CFP · 2352x1568 · 45-degree field of view
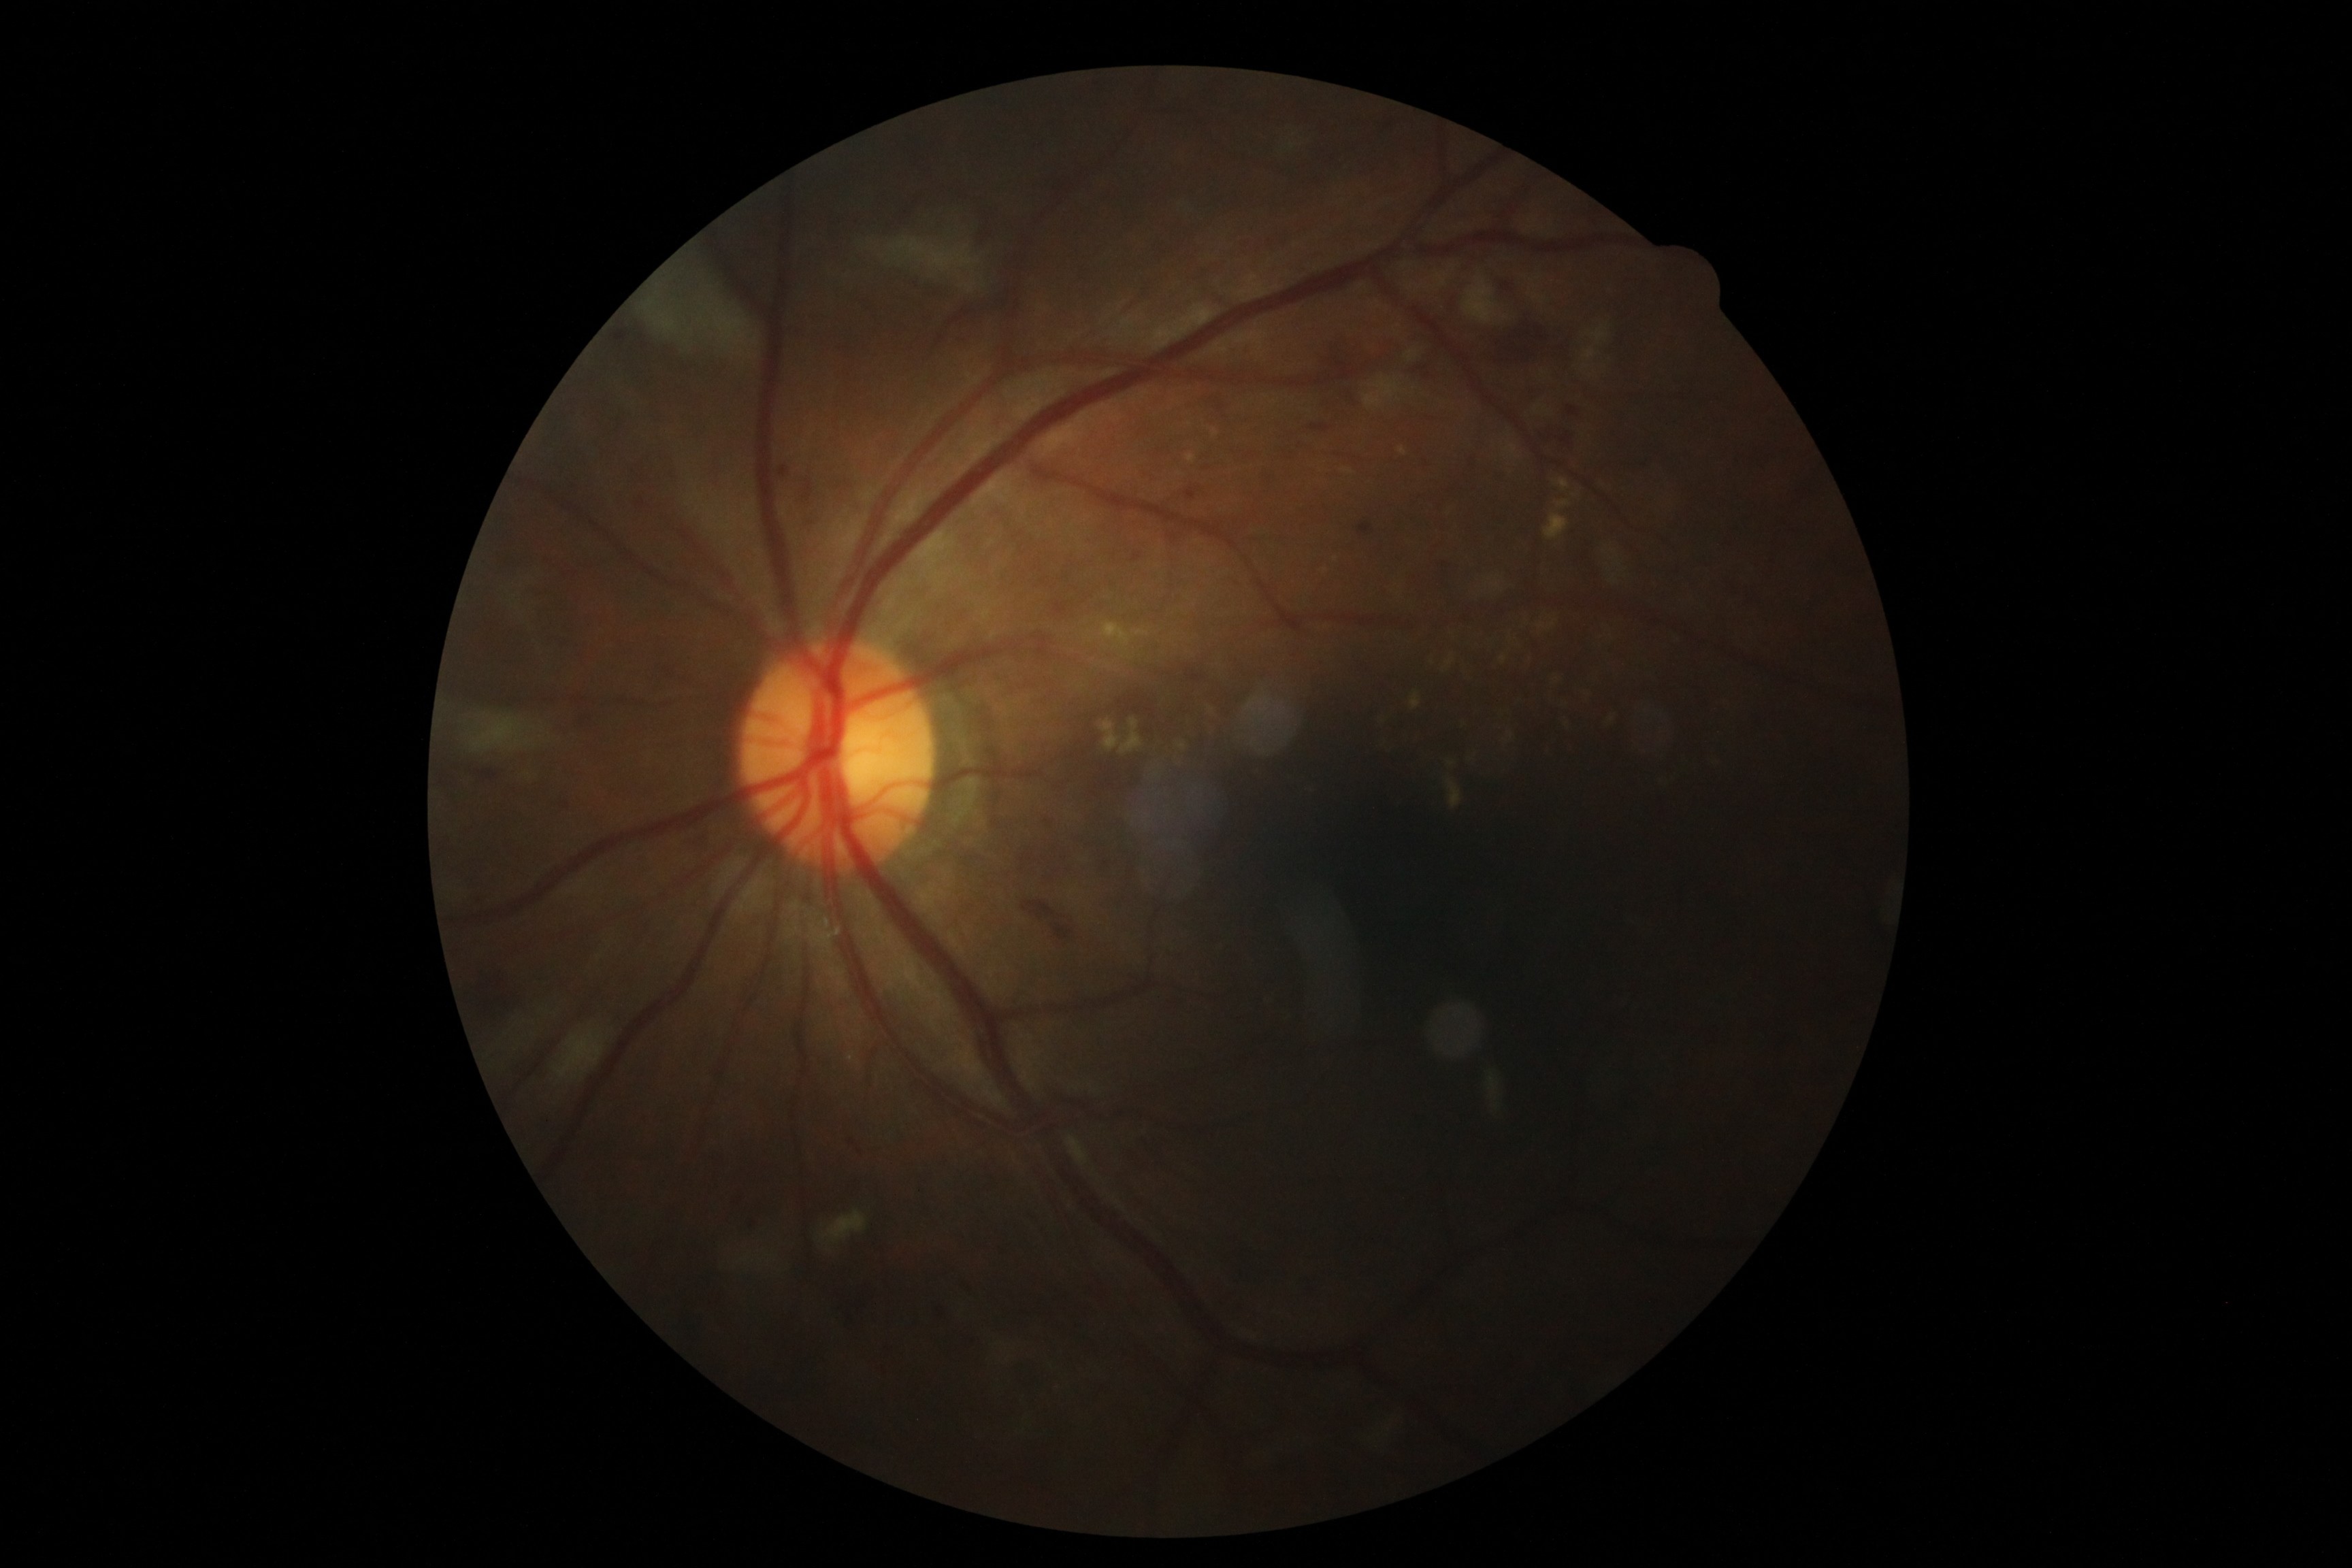 The retinopathy is classified as non-proliferative diabetic retinopathy. Diabetic retinopathy (DR) is 2.